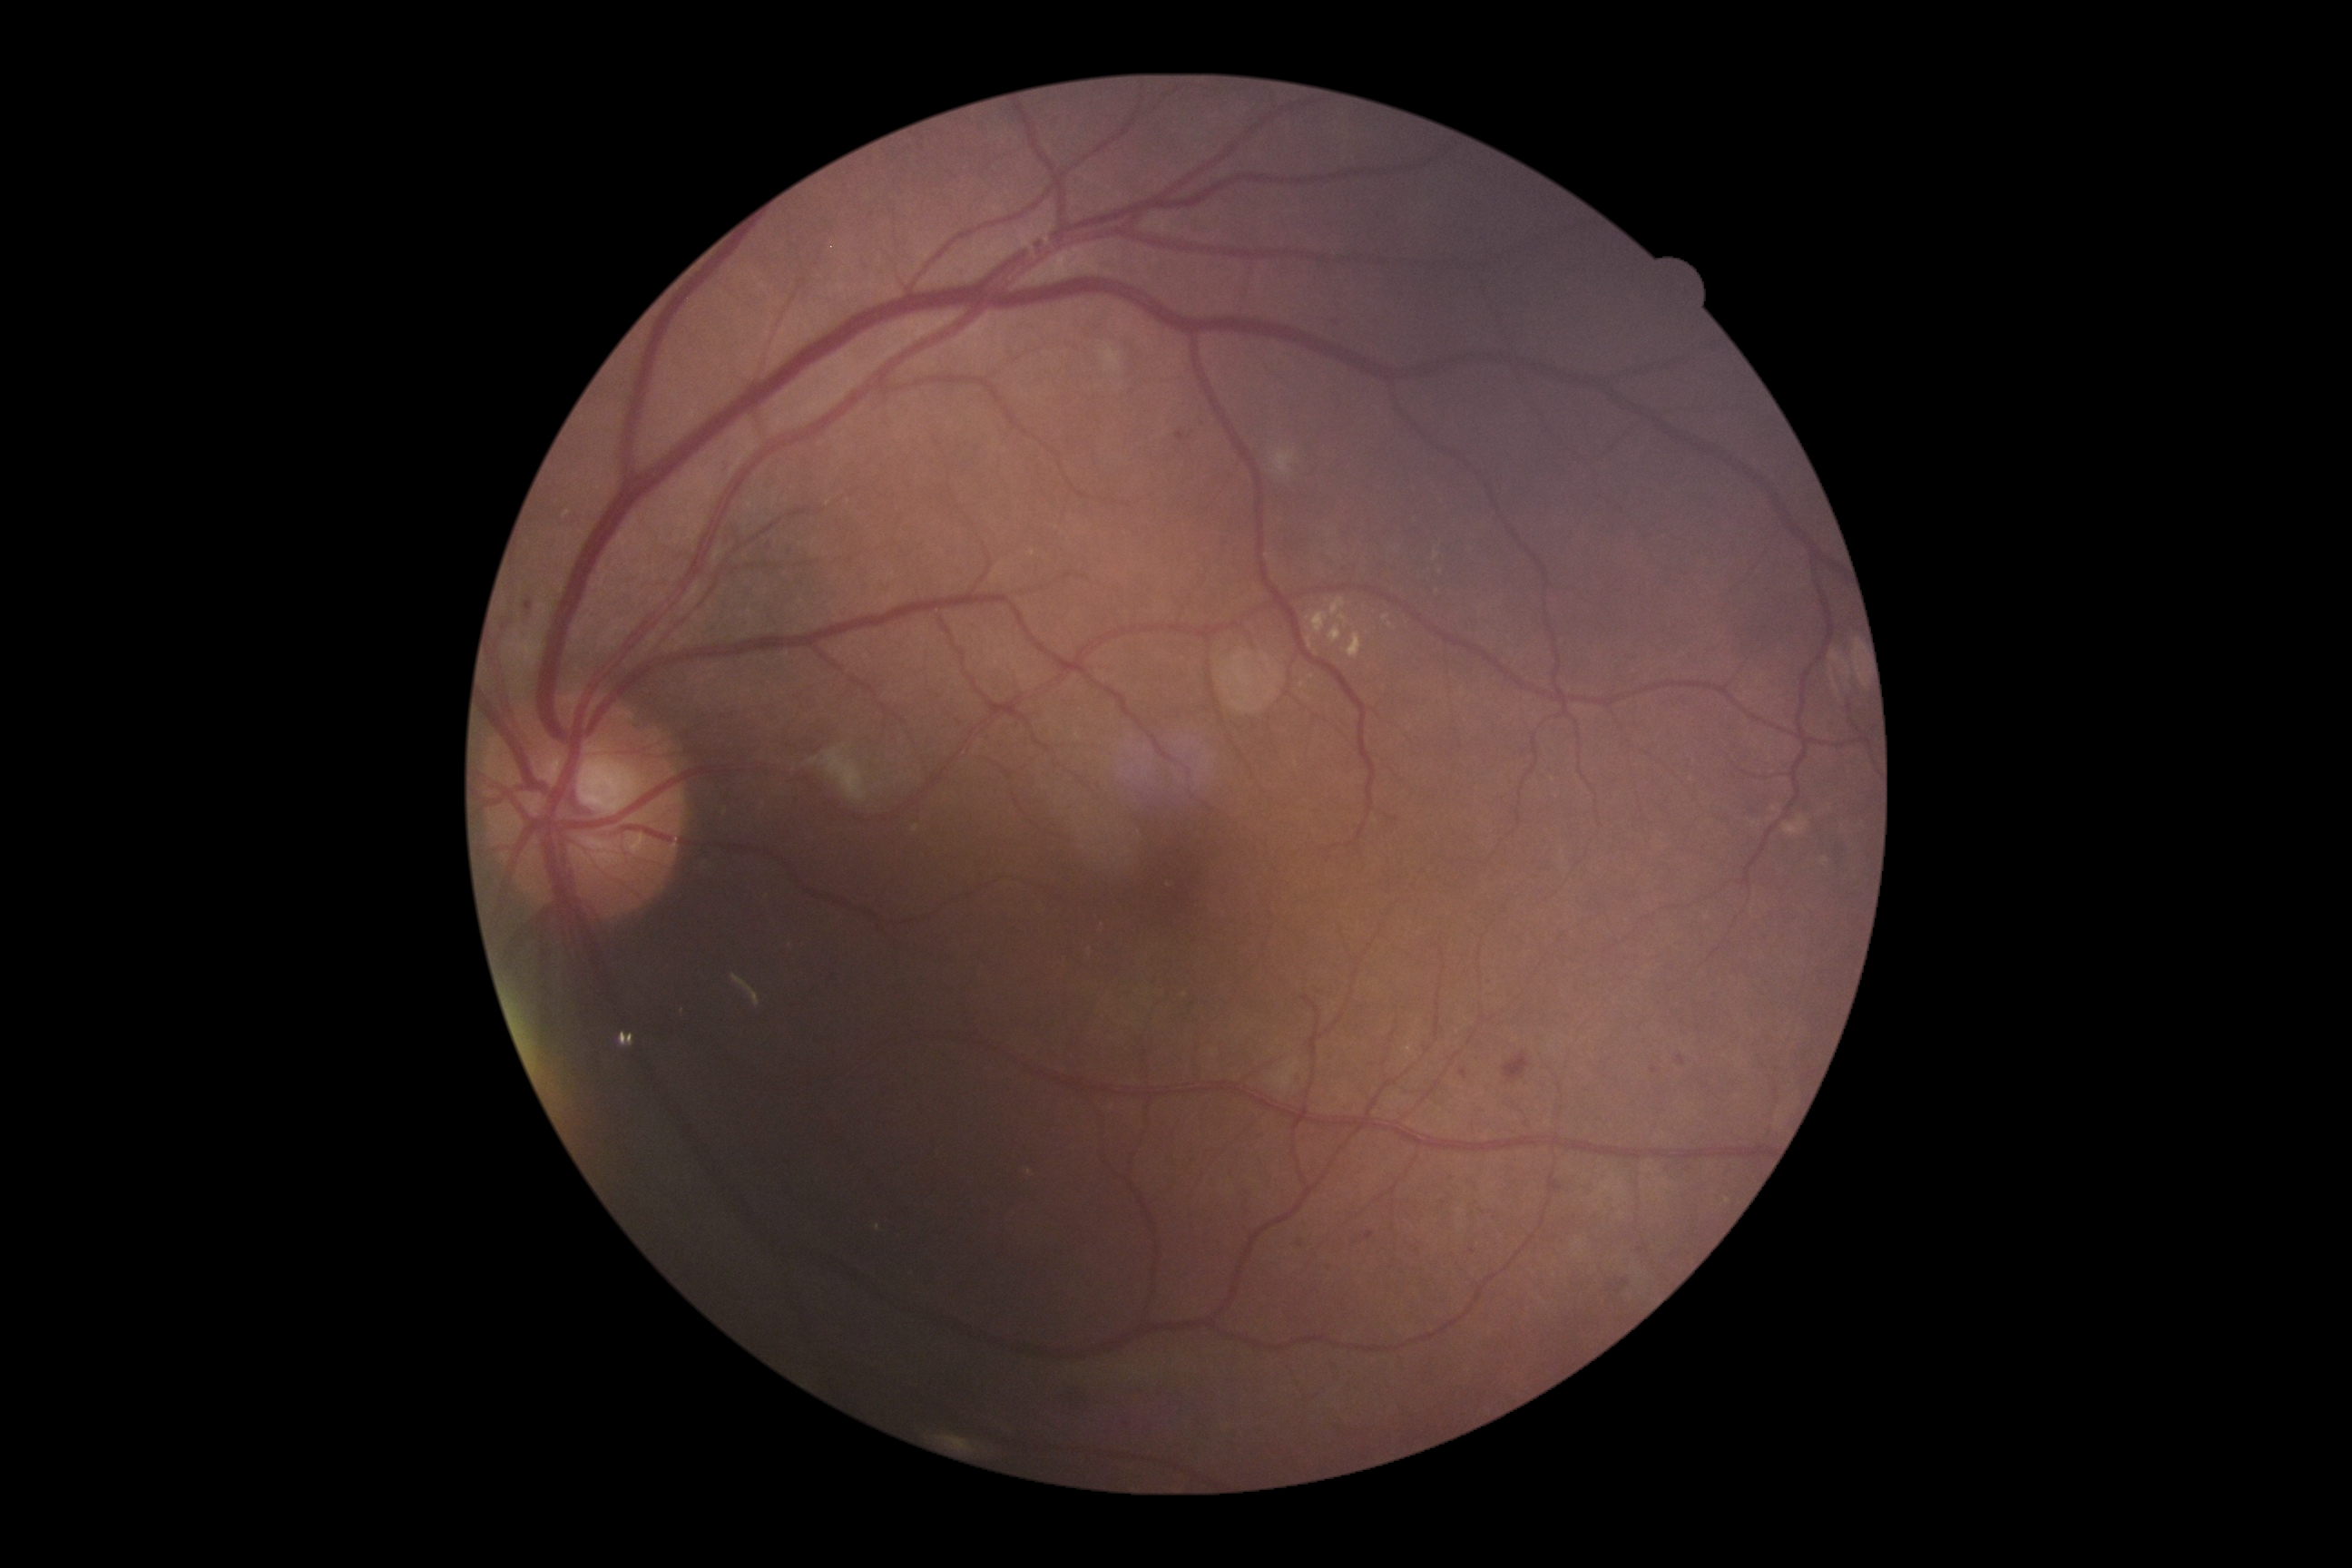 DR grade is 2 (moderate NPDR); non-proliferative diabetic retinopathy
A subset of detected lesions:
* HEs: bbox=[1504, 1052, 1531, 1084]
* SEs: bbox=[823, 749, 868, 801], bbox=[1273, 447, 1297, 476], bbox=[1785, 816, 1810, 836], bbox=[1101, 344, 1124, 373]
* EXs (continued): bbox=[1329, 625, 1342, 643], bbox=[1308, 612, 1329, 632], bbox=[1338, 614, 1349, 627], bbox=[1300, 681, 1306, 689], bbox=[1382, 614, 1391, 622], bbox=[1348, 632, 1362, 660], bbox=[1387, 623, 1395, 629], bbox=[1331, 598, 1346, 618], bbox=[1308, 638, 1313, 649]
* Smaller EXs around [1437,556], [1755,825], [1775,809], [1312,677], [1438,592], [1824,861]
* MAs (continued): bbox=[1153, 975, 1157, 983], bbox=[1366, 1233, 1375, 1240], bbox=[1547, 1173, 1563, 1193], bbox=[1447, 1175, 1458, 1186], bbox=[524, 602, 533, 611], bbox=[1460, 1070, 1469, 1081], bbox=[1623, 1280, 1631, 1288], bbox=[1177, 433, 1184, 442], bbox=[1612, 1286, 1622, 1293], bbox=[1331, 1266, 1335, 1275], bbox=[1678, 1055, 1685, 1066]
* Smaller MAs around [769,546], [793,550], [1298,1080], [1472,1252], [1654,1070]